FOV: 45 degrees:
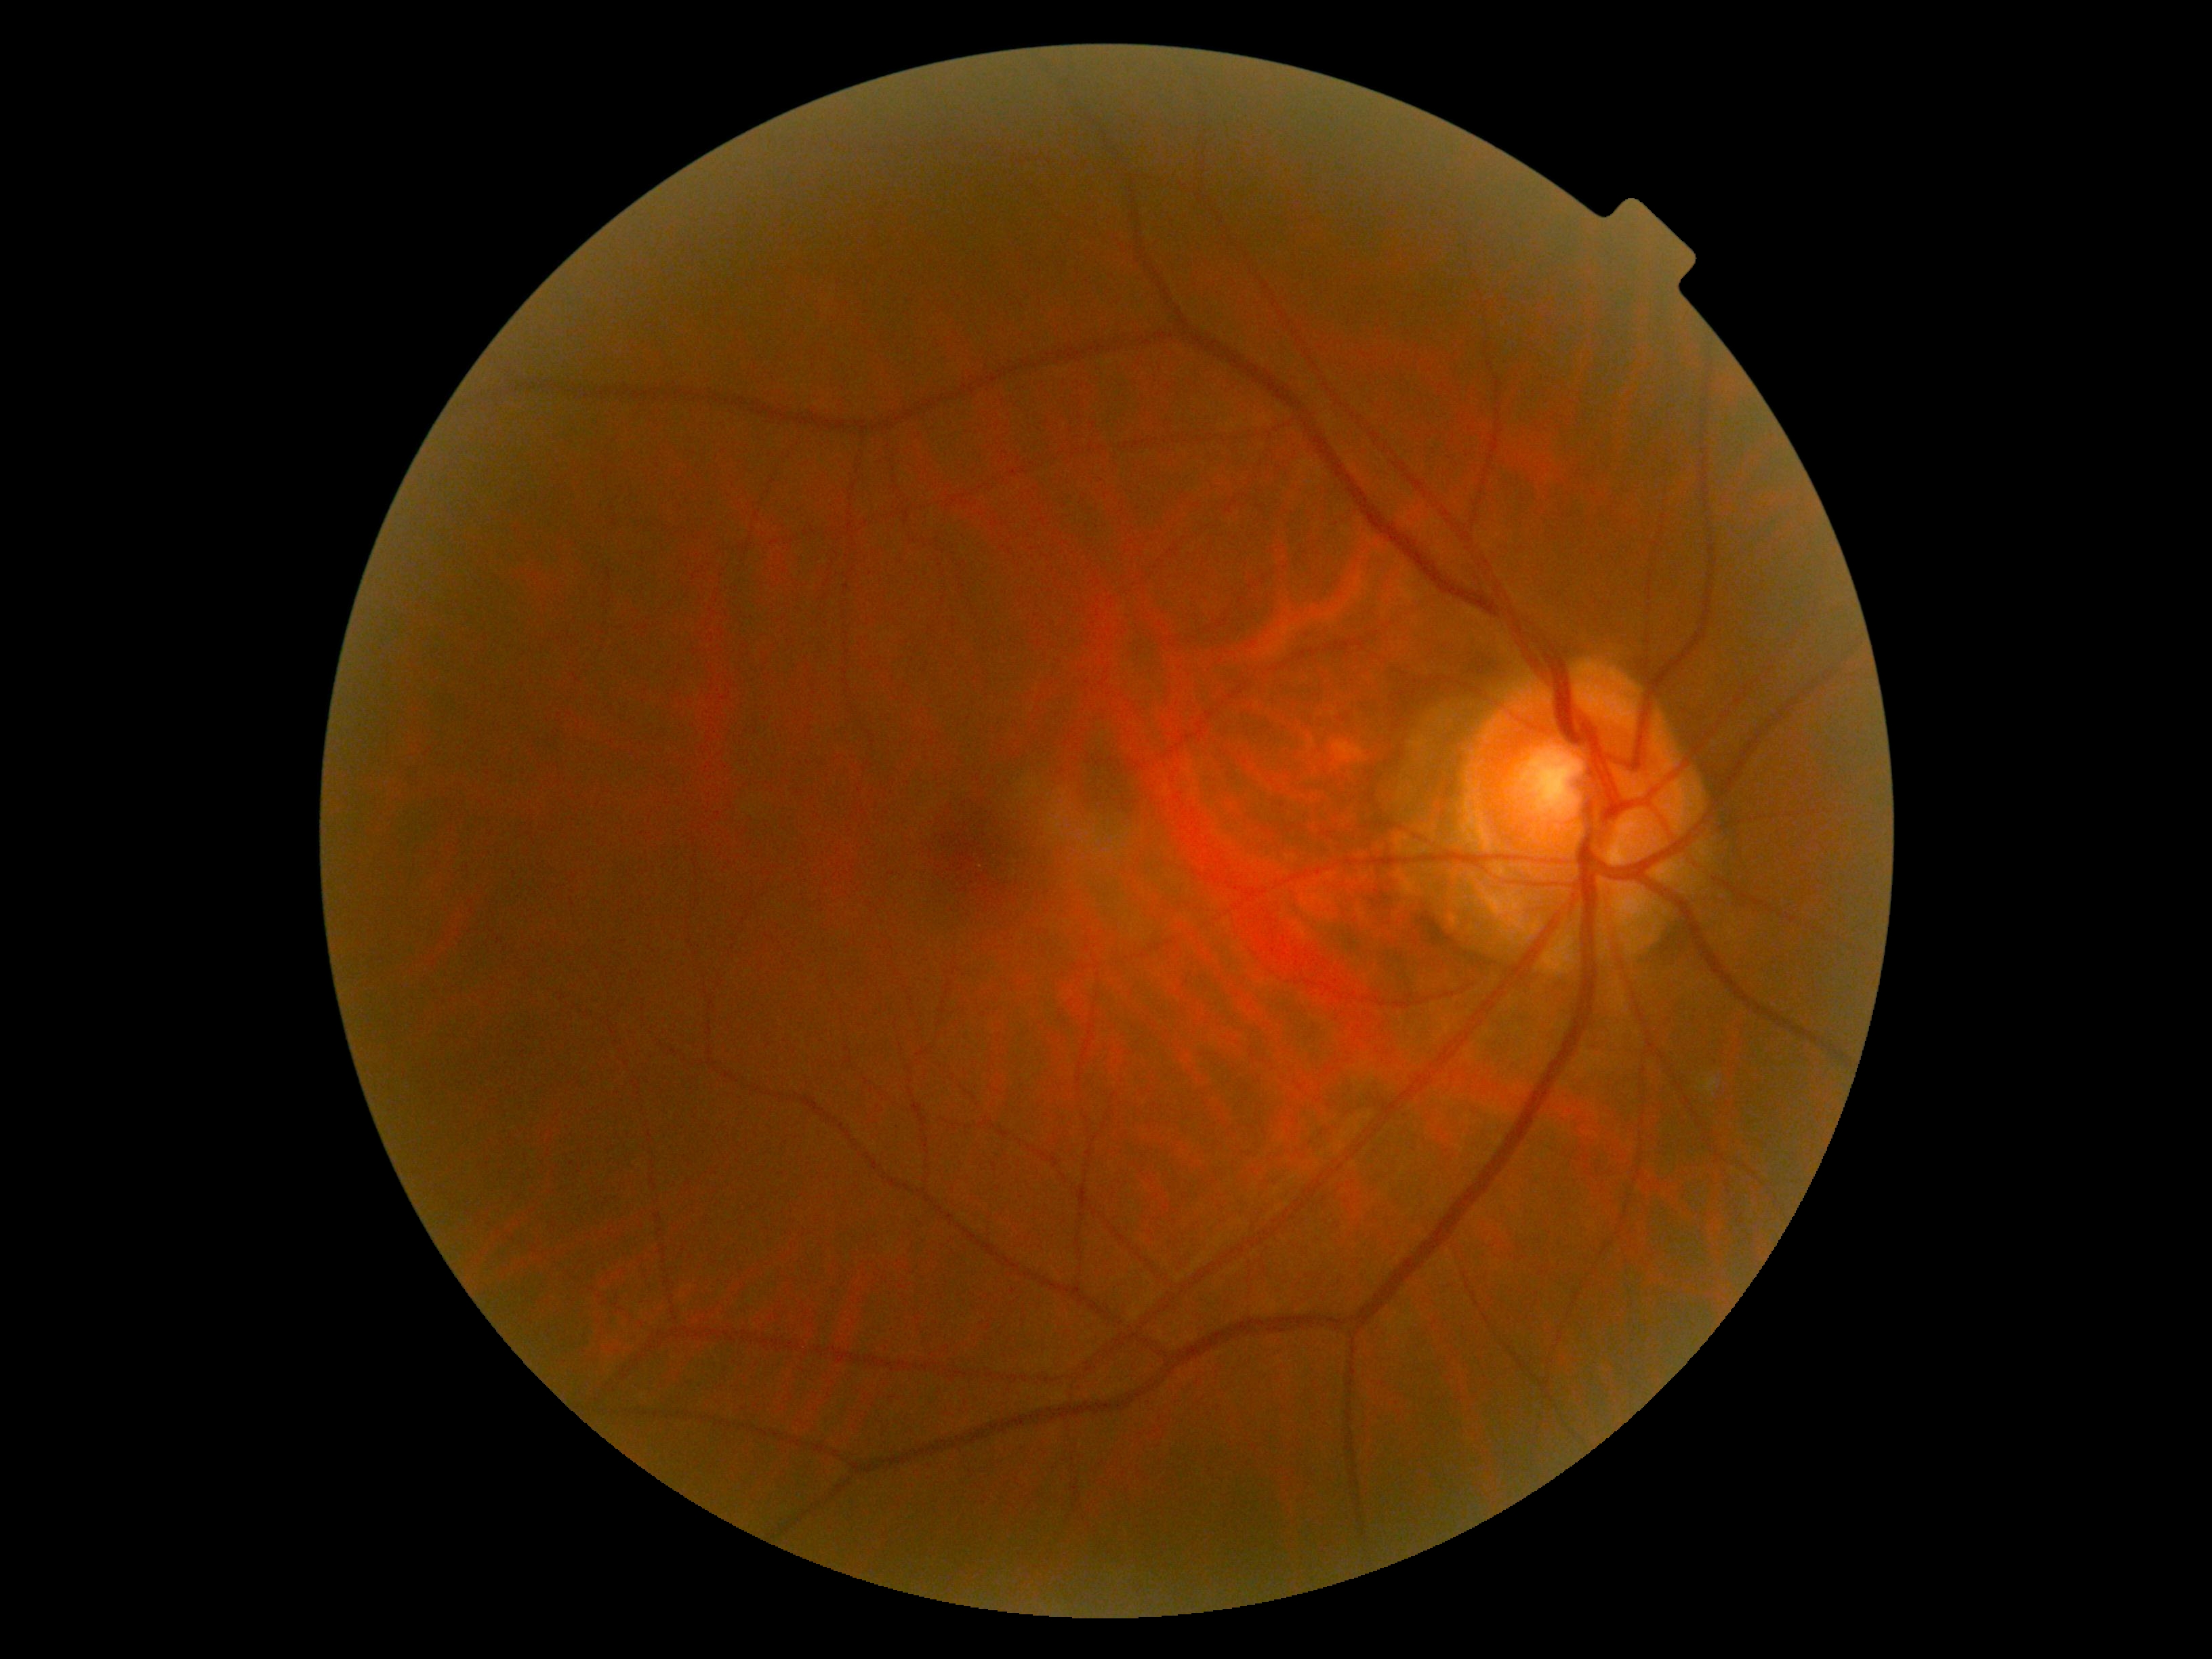 diabetic retinopathy grade=0 (no apparent retinopathy) — no visible signs of diabetic retinopathy.